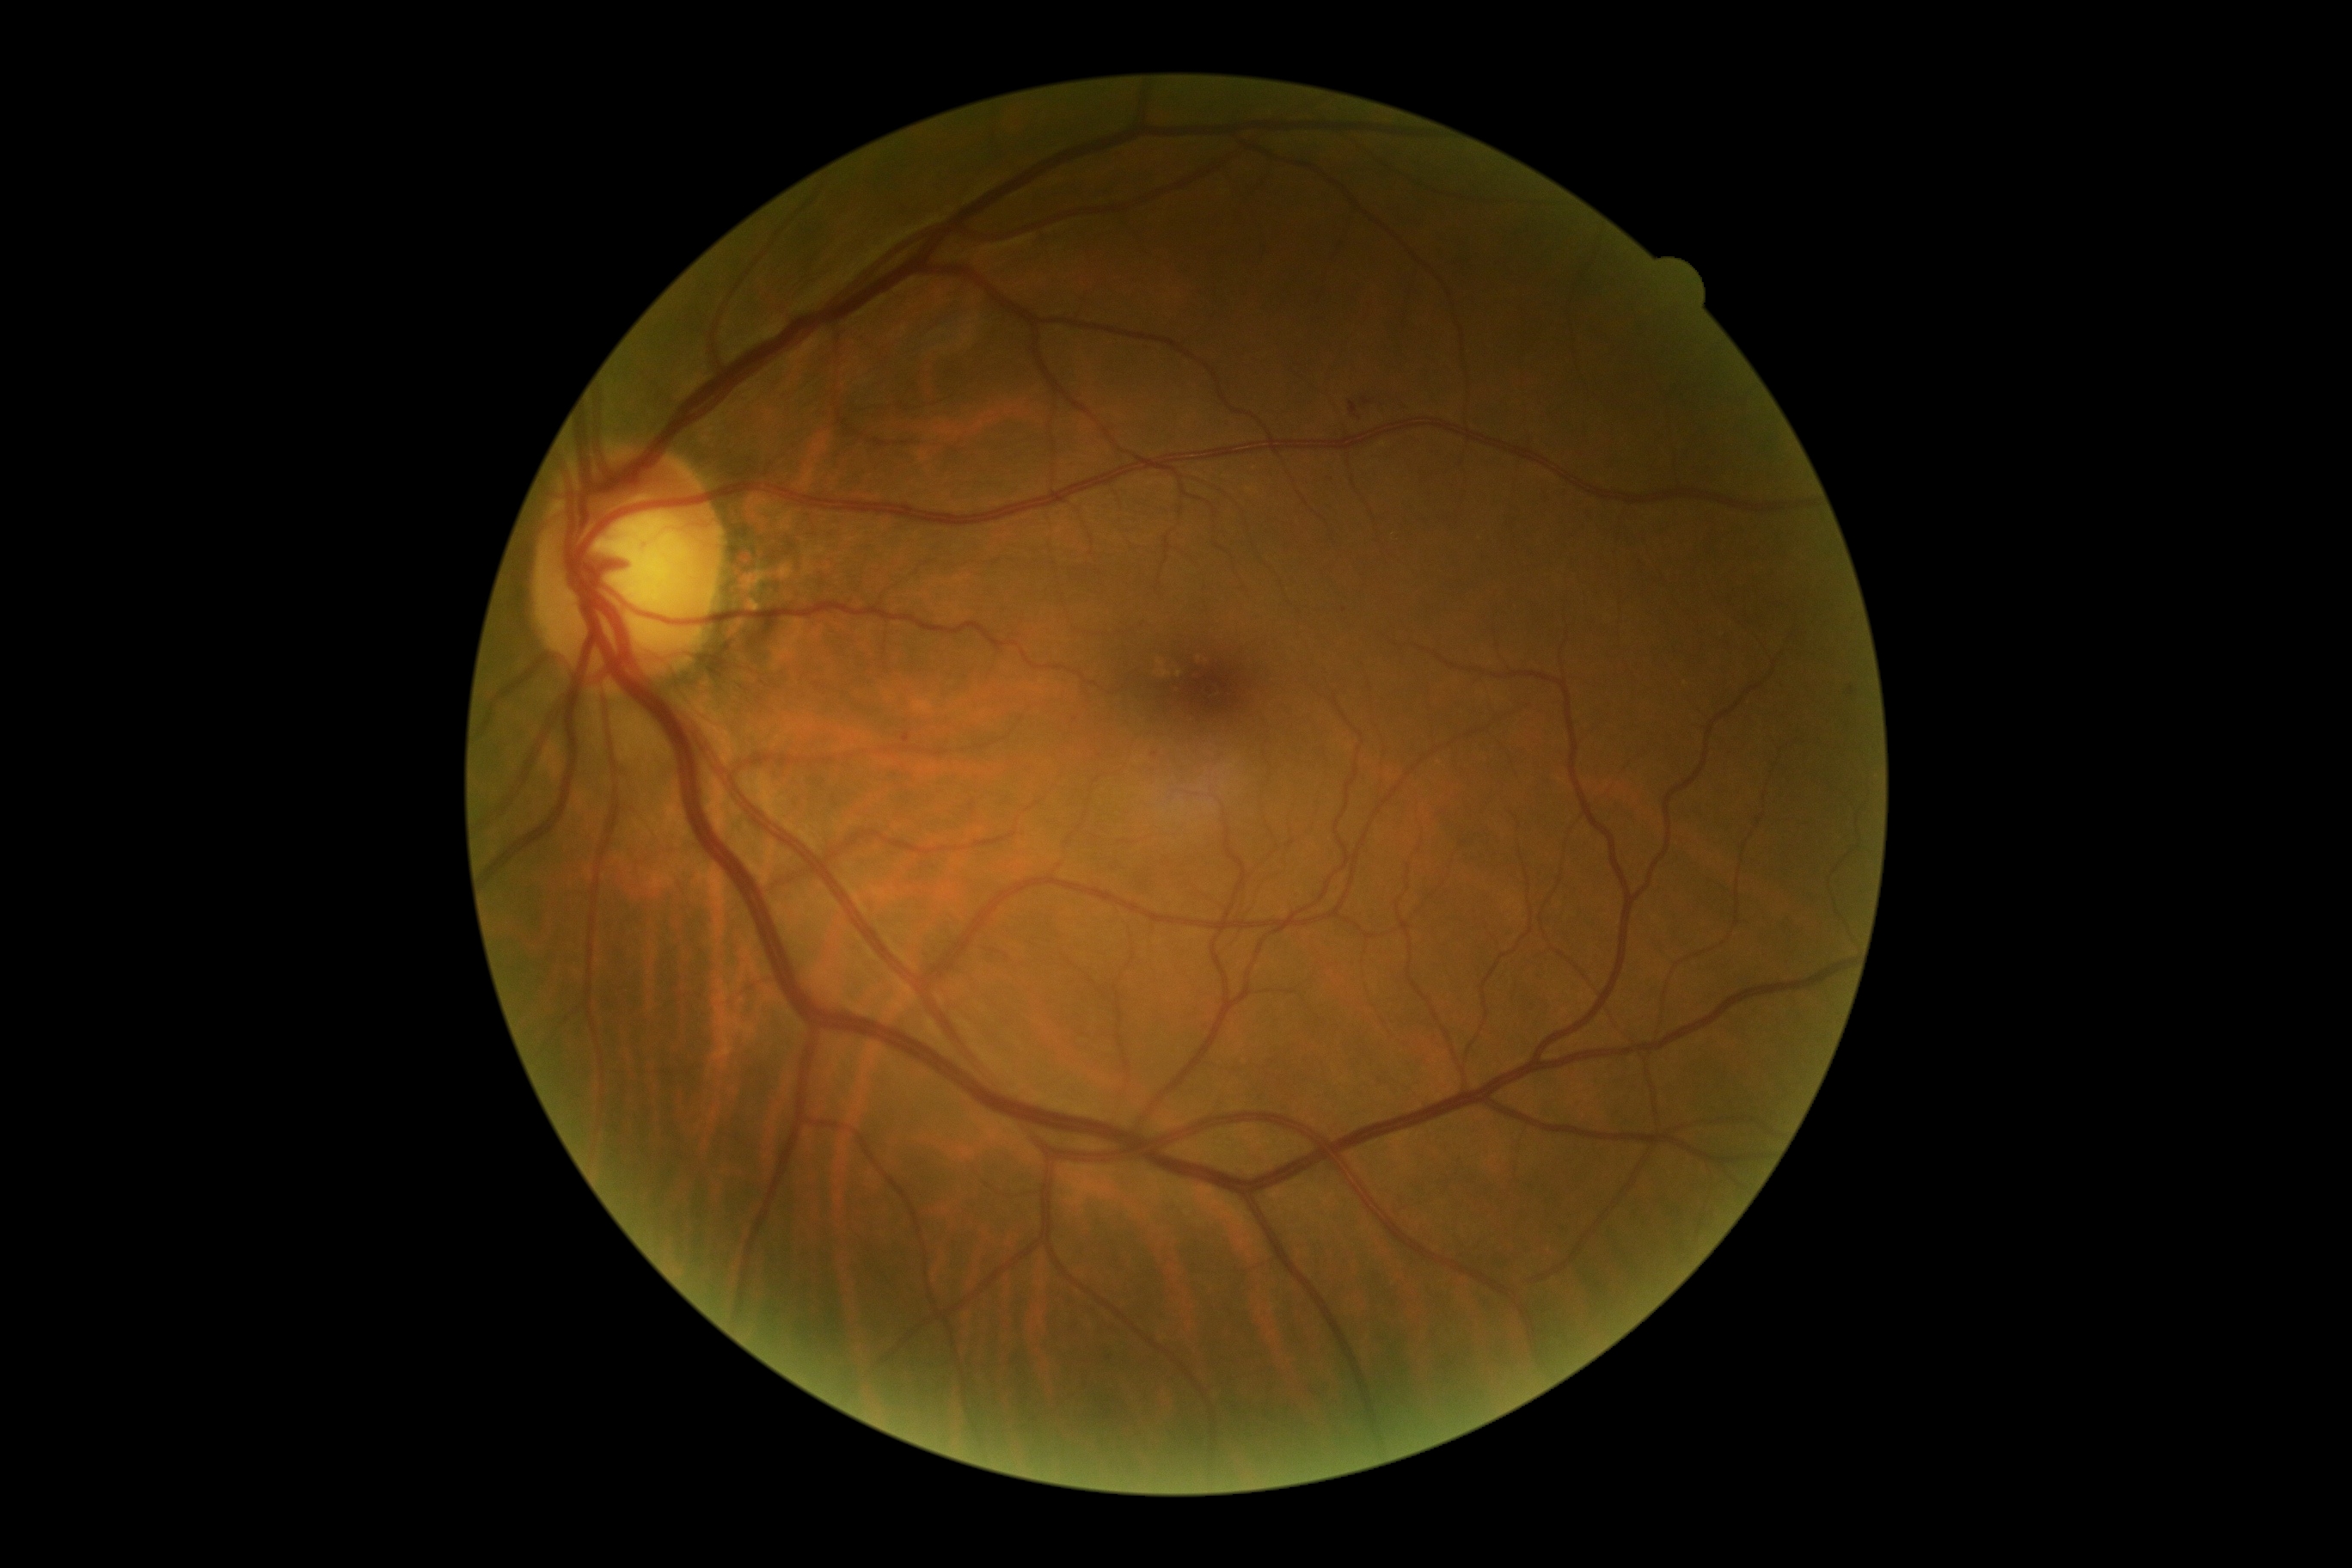 Diabetic retinopathy is grade 2.